Retinal fundus photograph, 848 x 848 pixels:
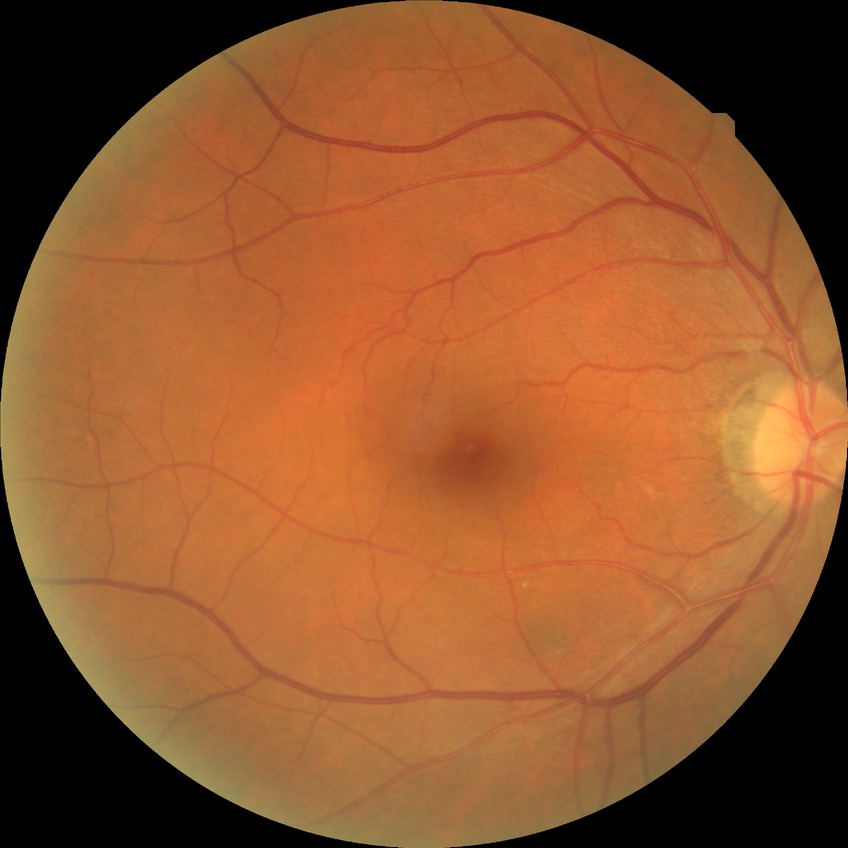
diabetic retinopathy (DR) = NDR (no diabetic retinopathy).